Without pupil dilation, Davis DR grading
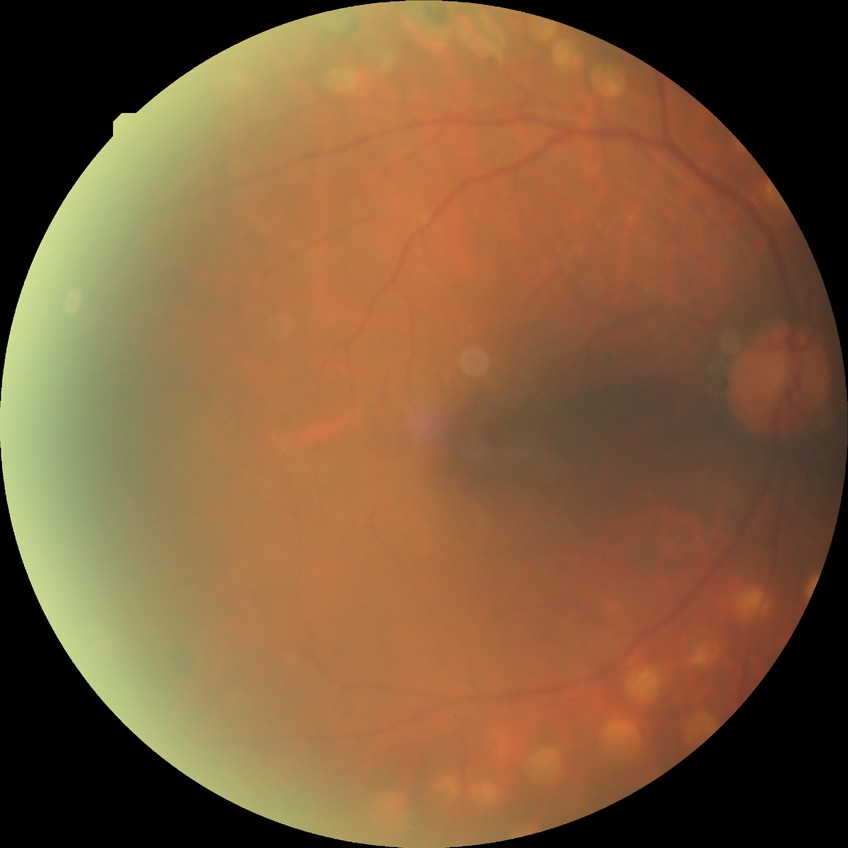

Diabetic retinopathy (DR) is proliferative diabetic retinopathy (PDR).